Wide-field fundus image from infant ROP screening; 640x480px; Clarity RetCam 3, 130° FOV — 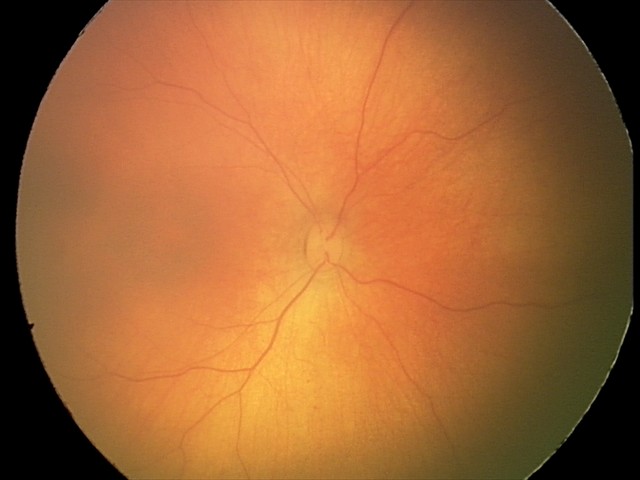 Physiological retinal appearance for postconceptual age.